FOV: 45 degrees
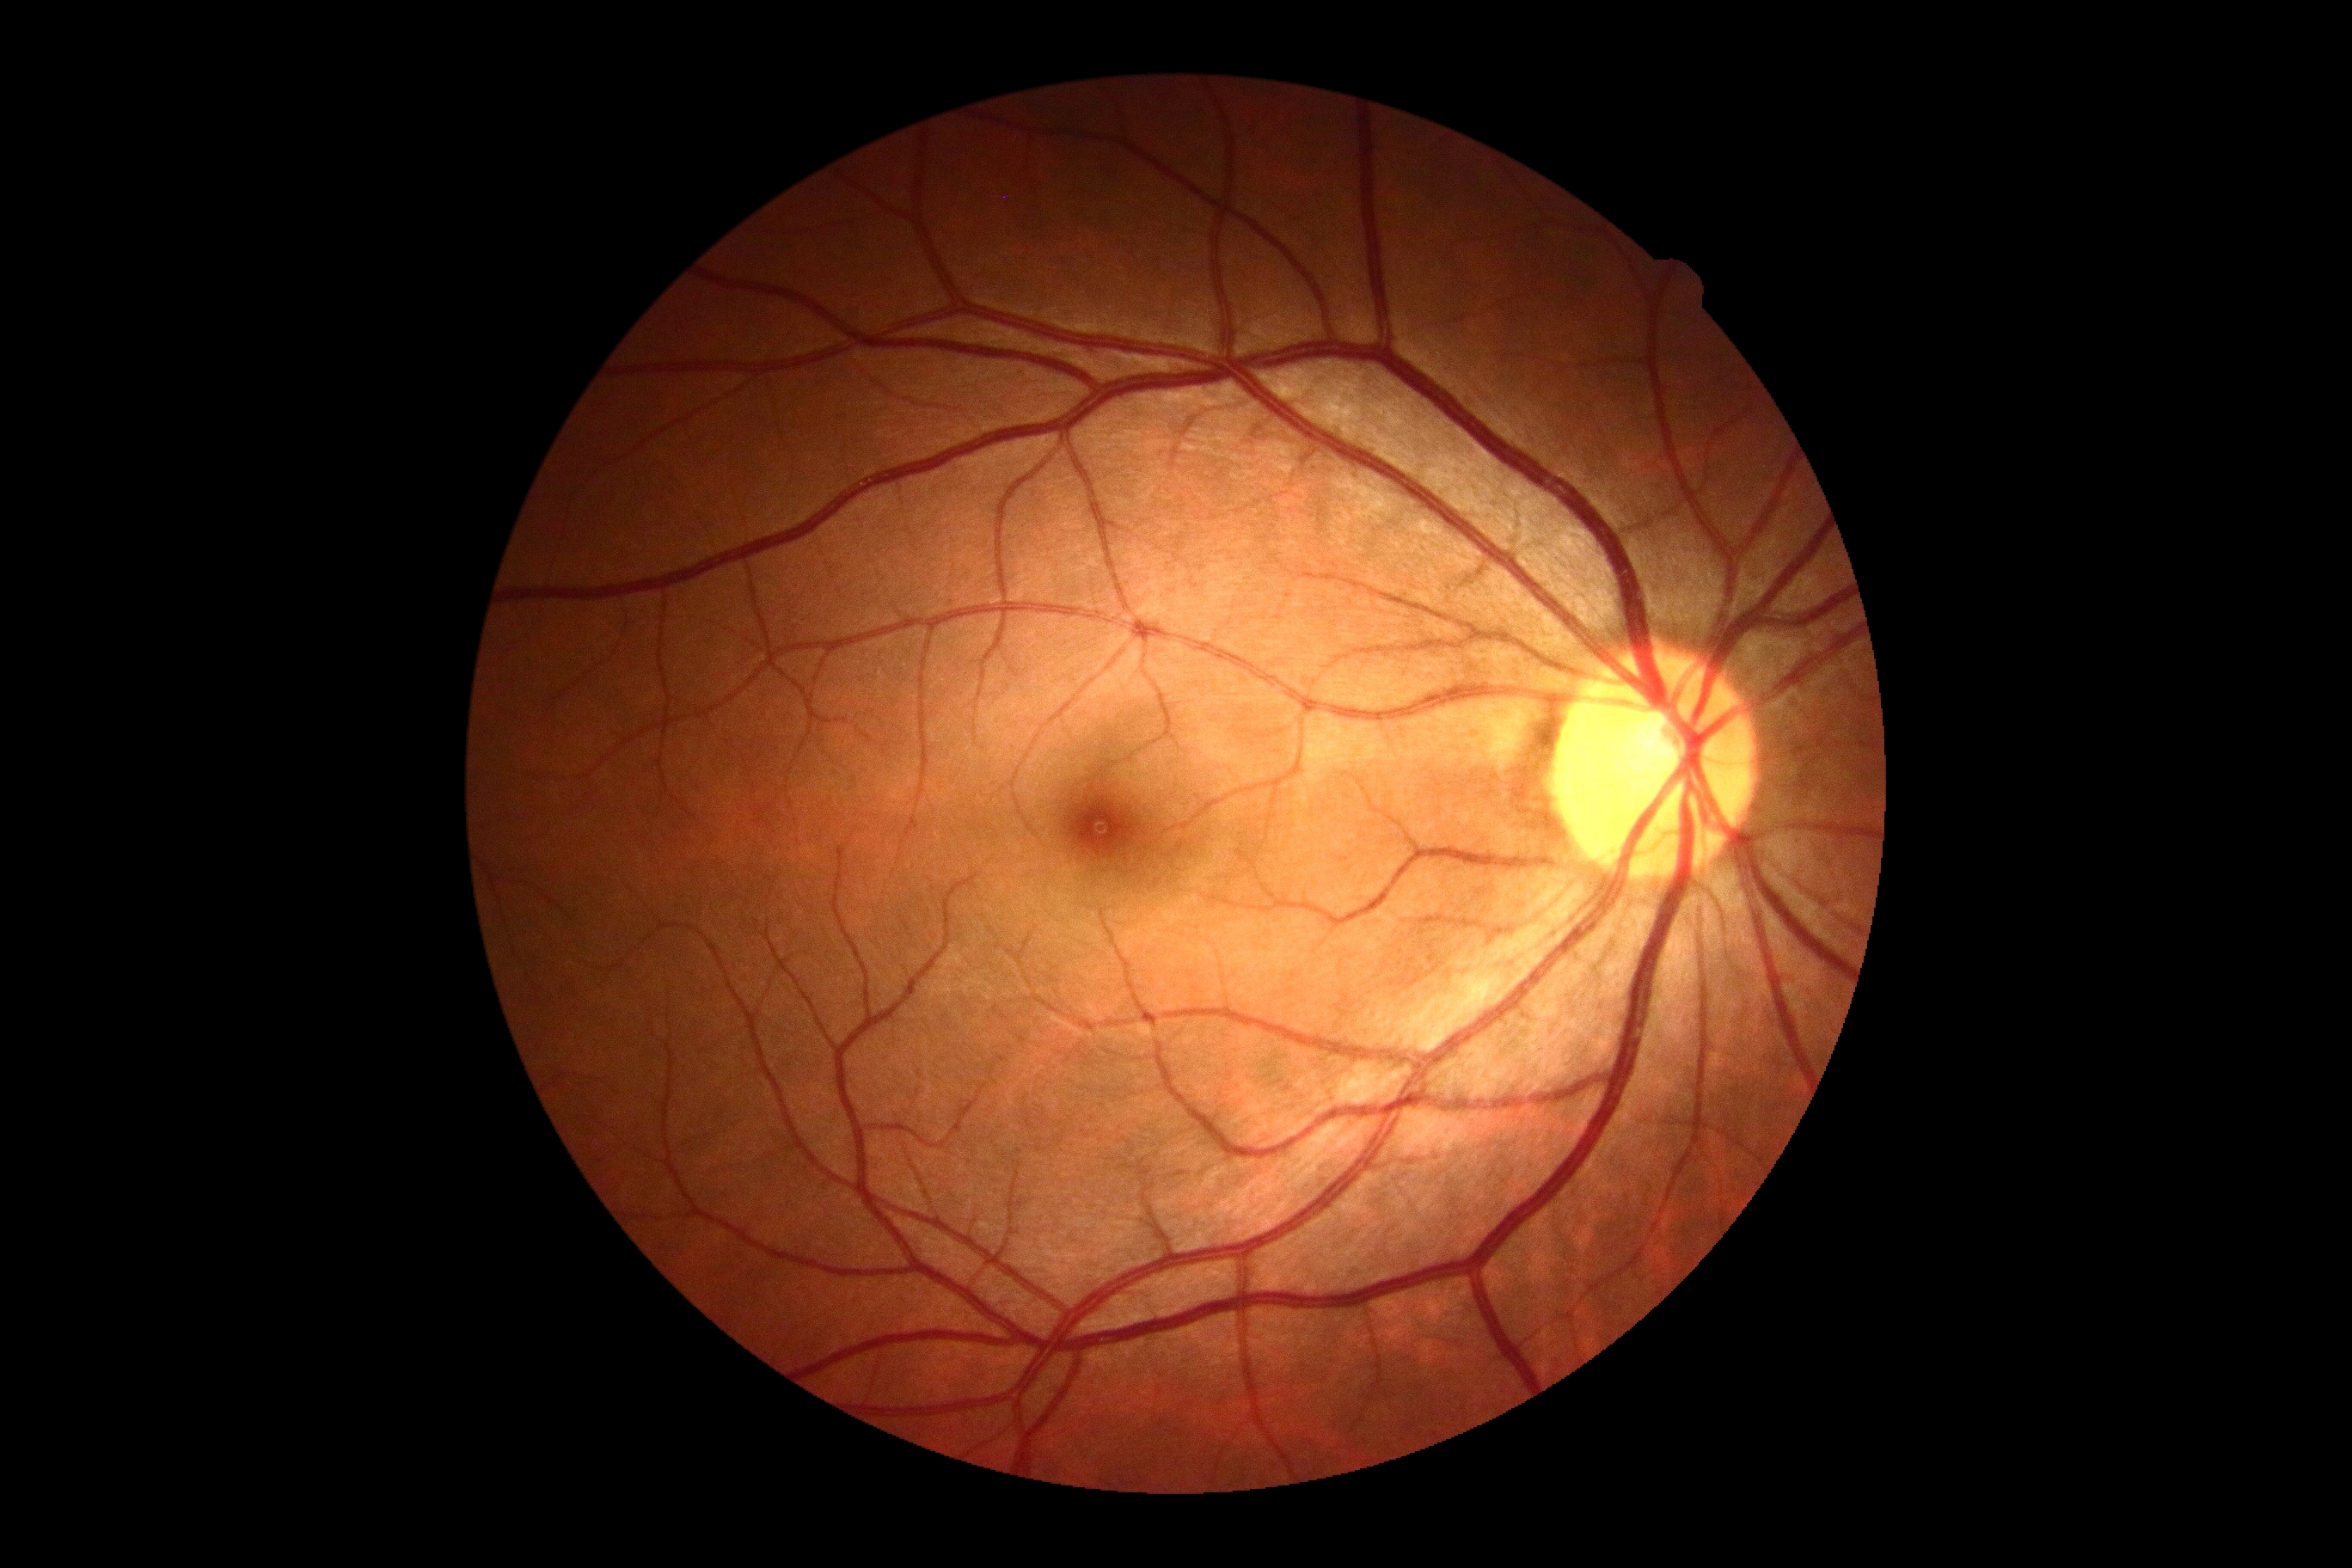 diabetic retinopathy grade = no apparent retinopathy (0).